Graded on the modified Davis scale — 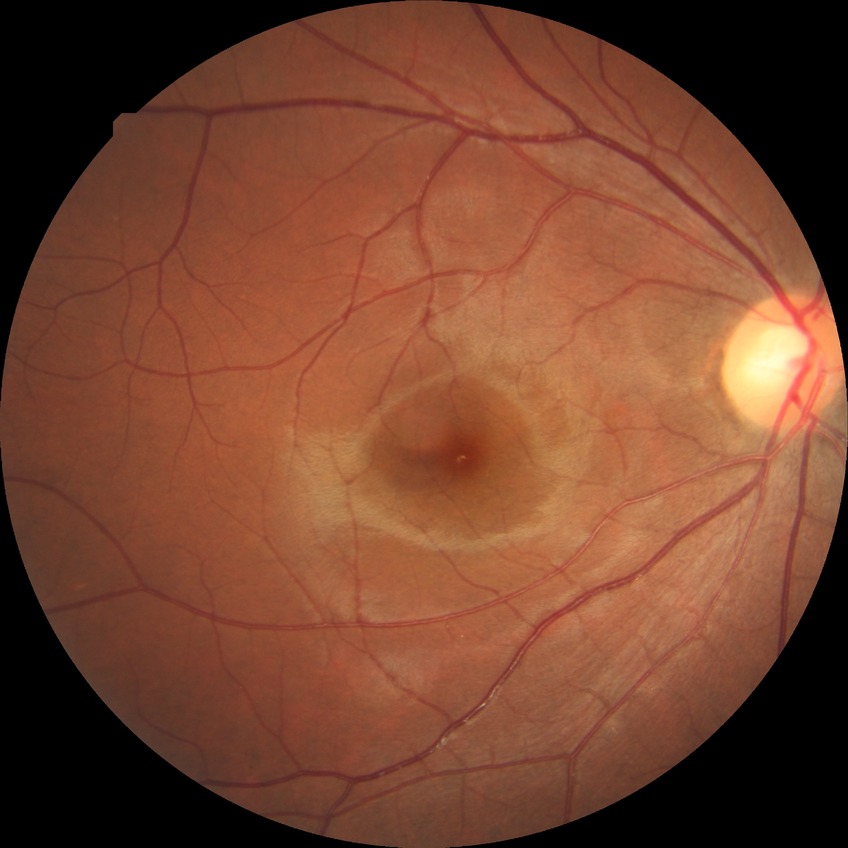
Diabetic retinopathy (DR) is no diabetic retinopathy (NDR).